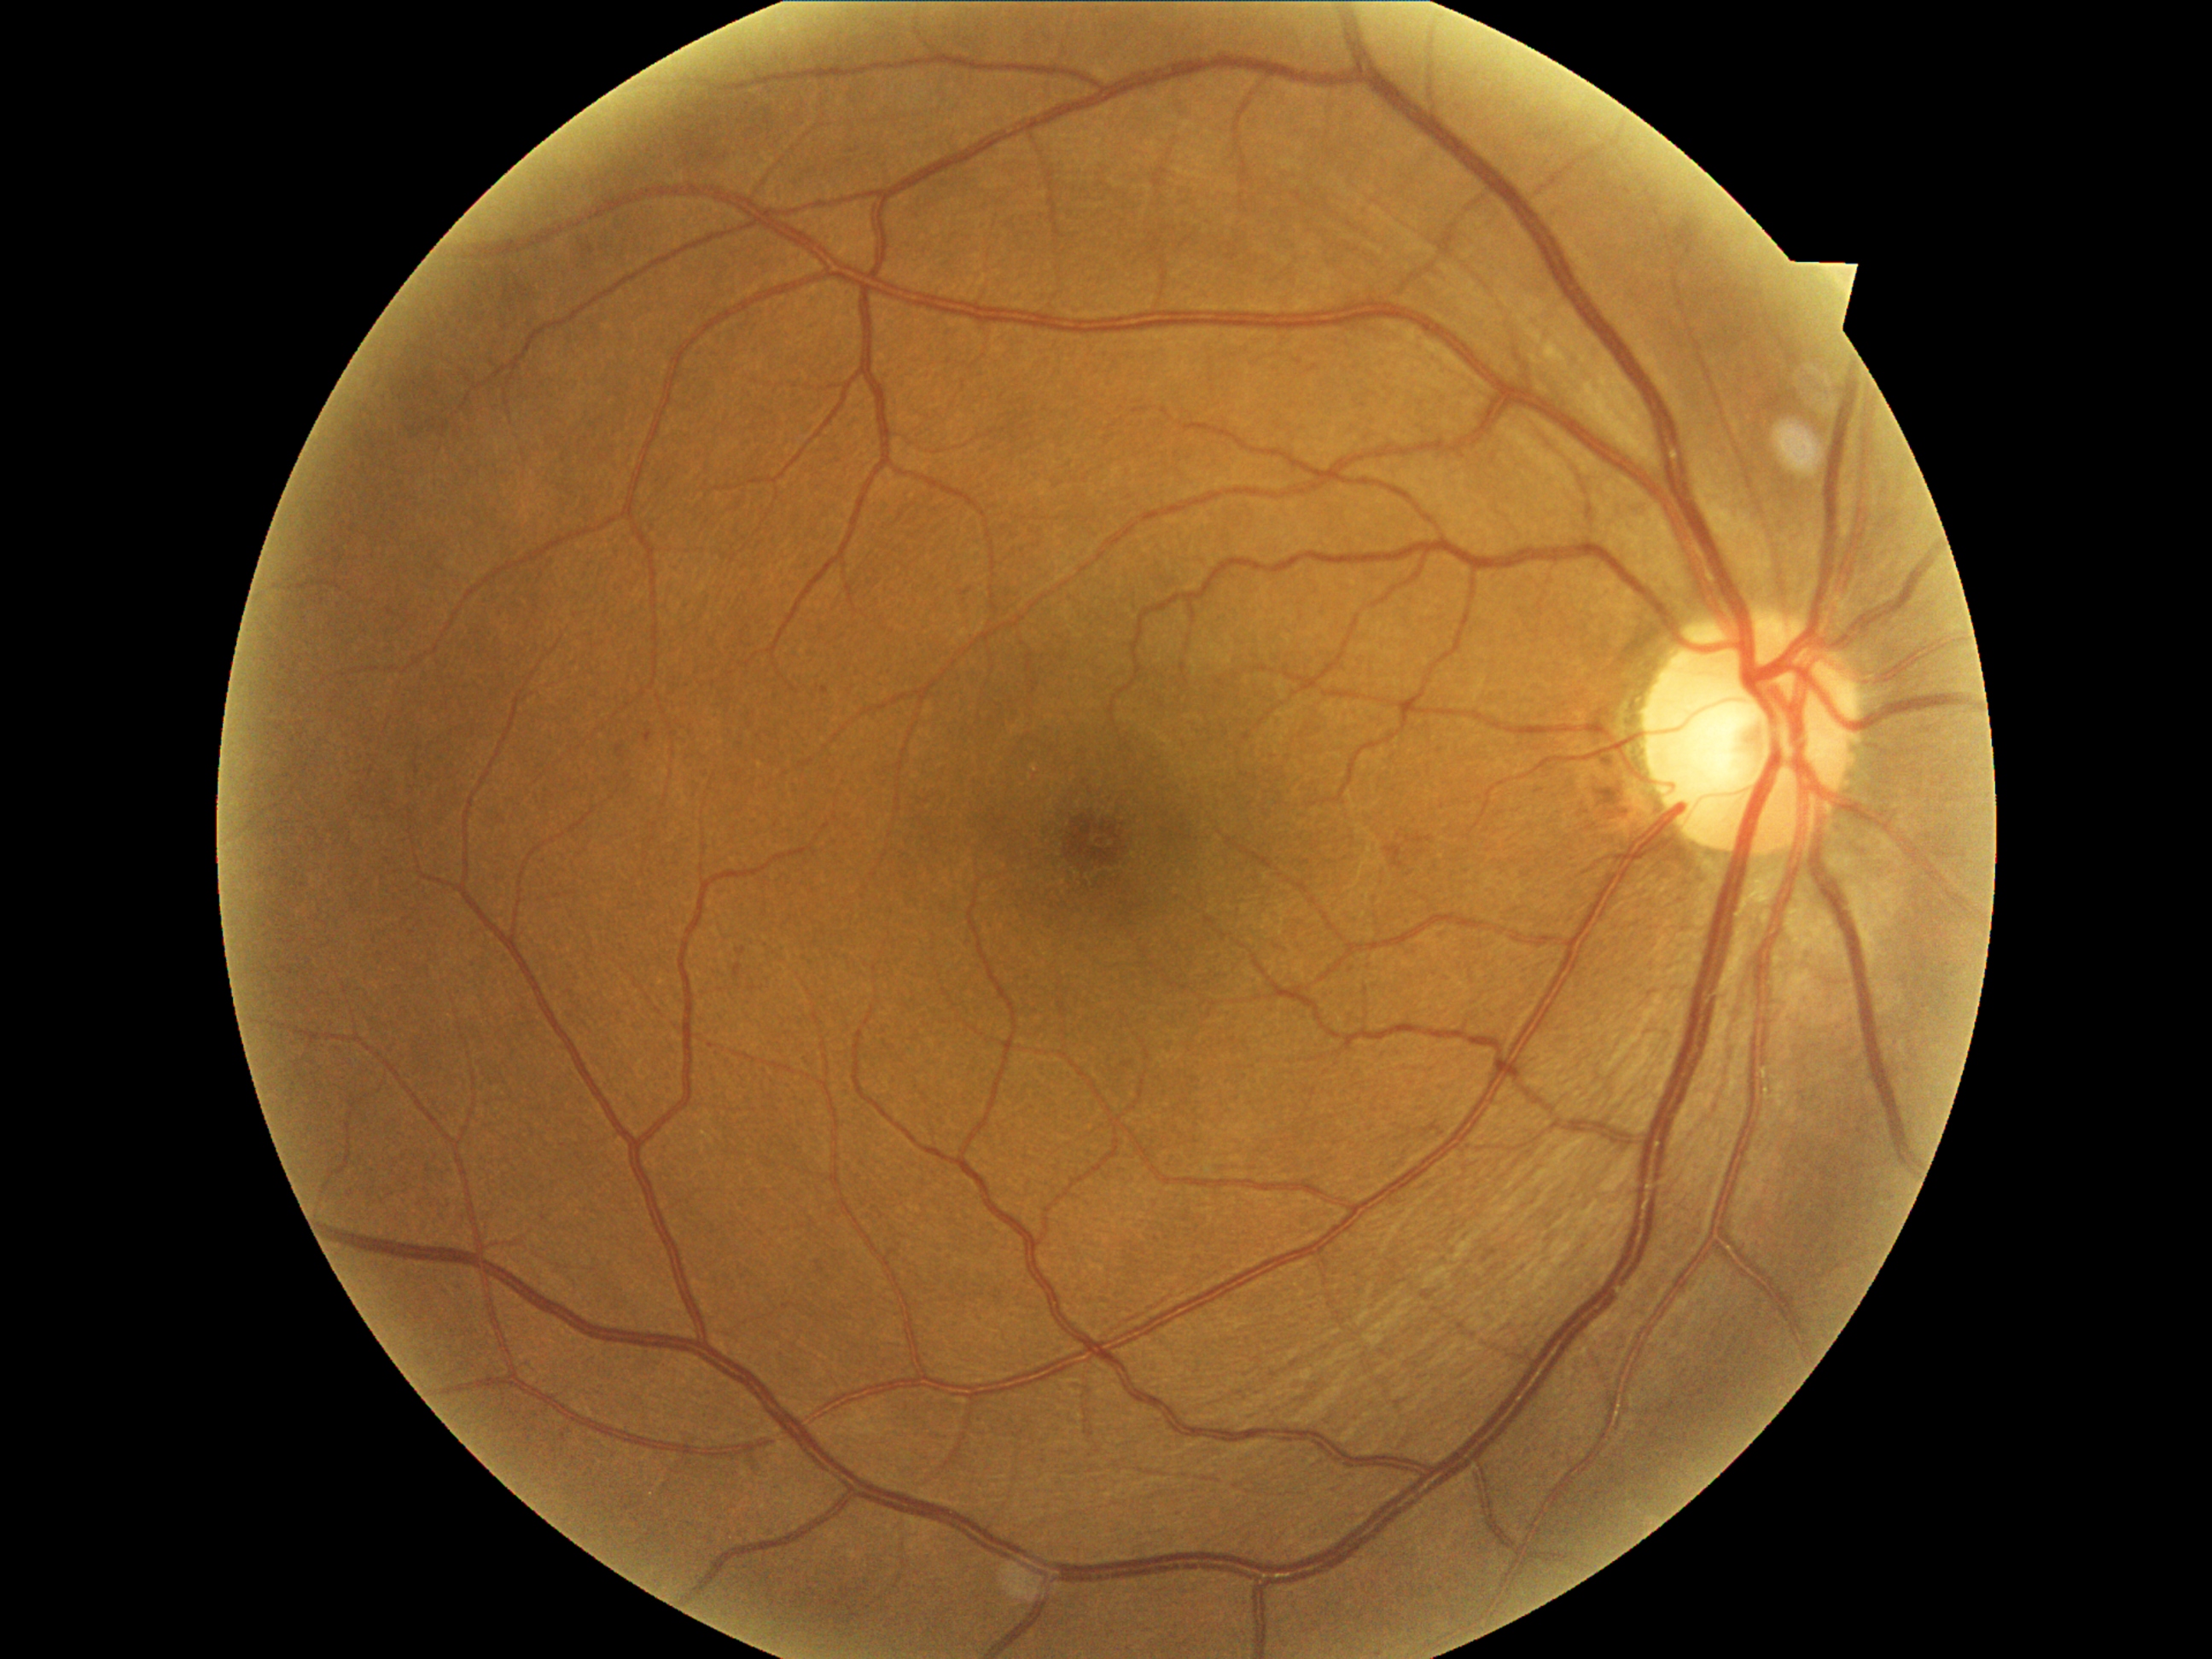

Diabetic retinopathy severity: mild NPDR (grade 1).